Color fundus photograph · 45° field of view
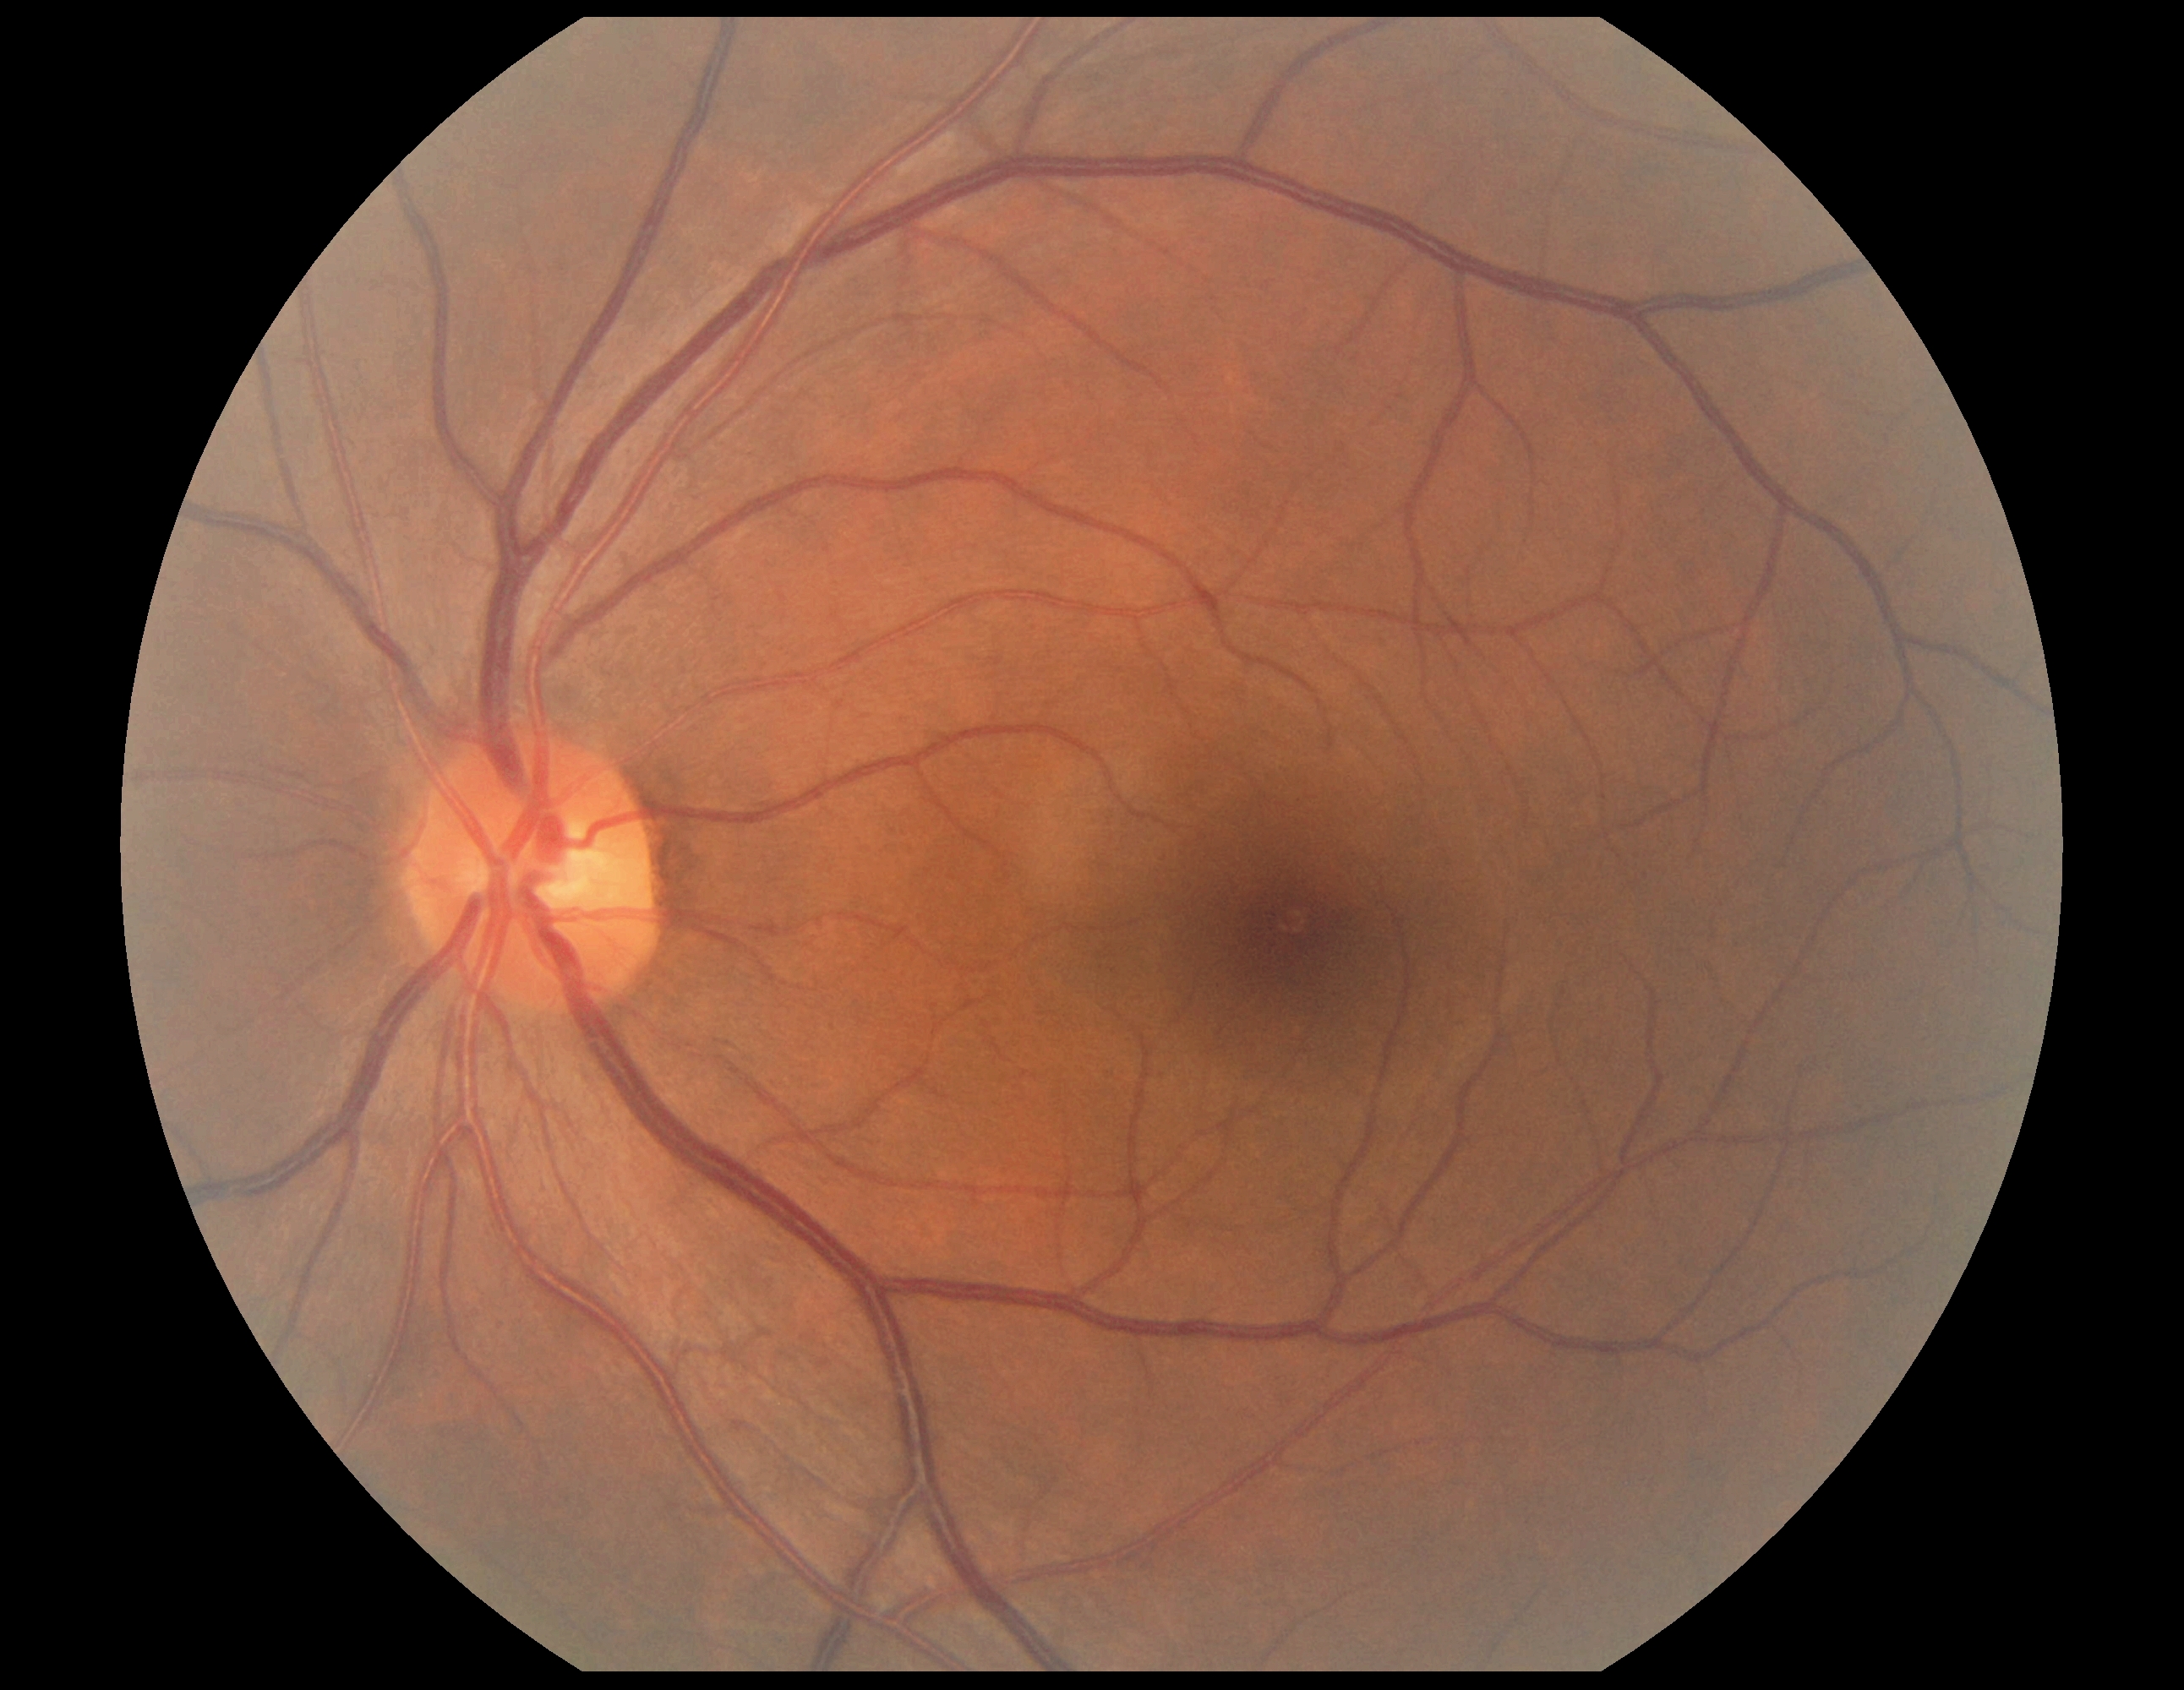

DR impression = no signs of DR, DR = grade 0 (no apparent retinopathy).